FOV: 45 degrees; 1932 by 1932 pixels — 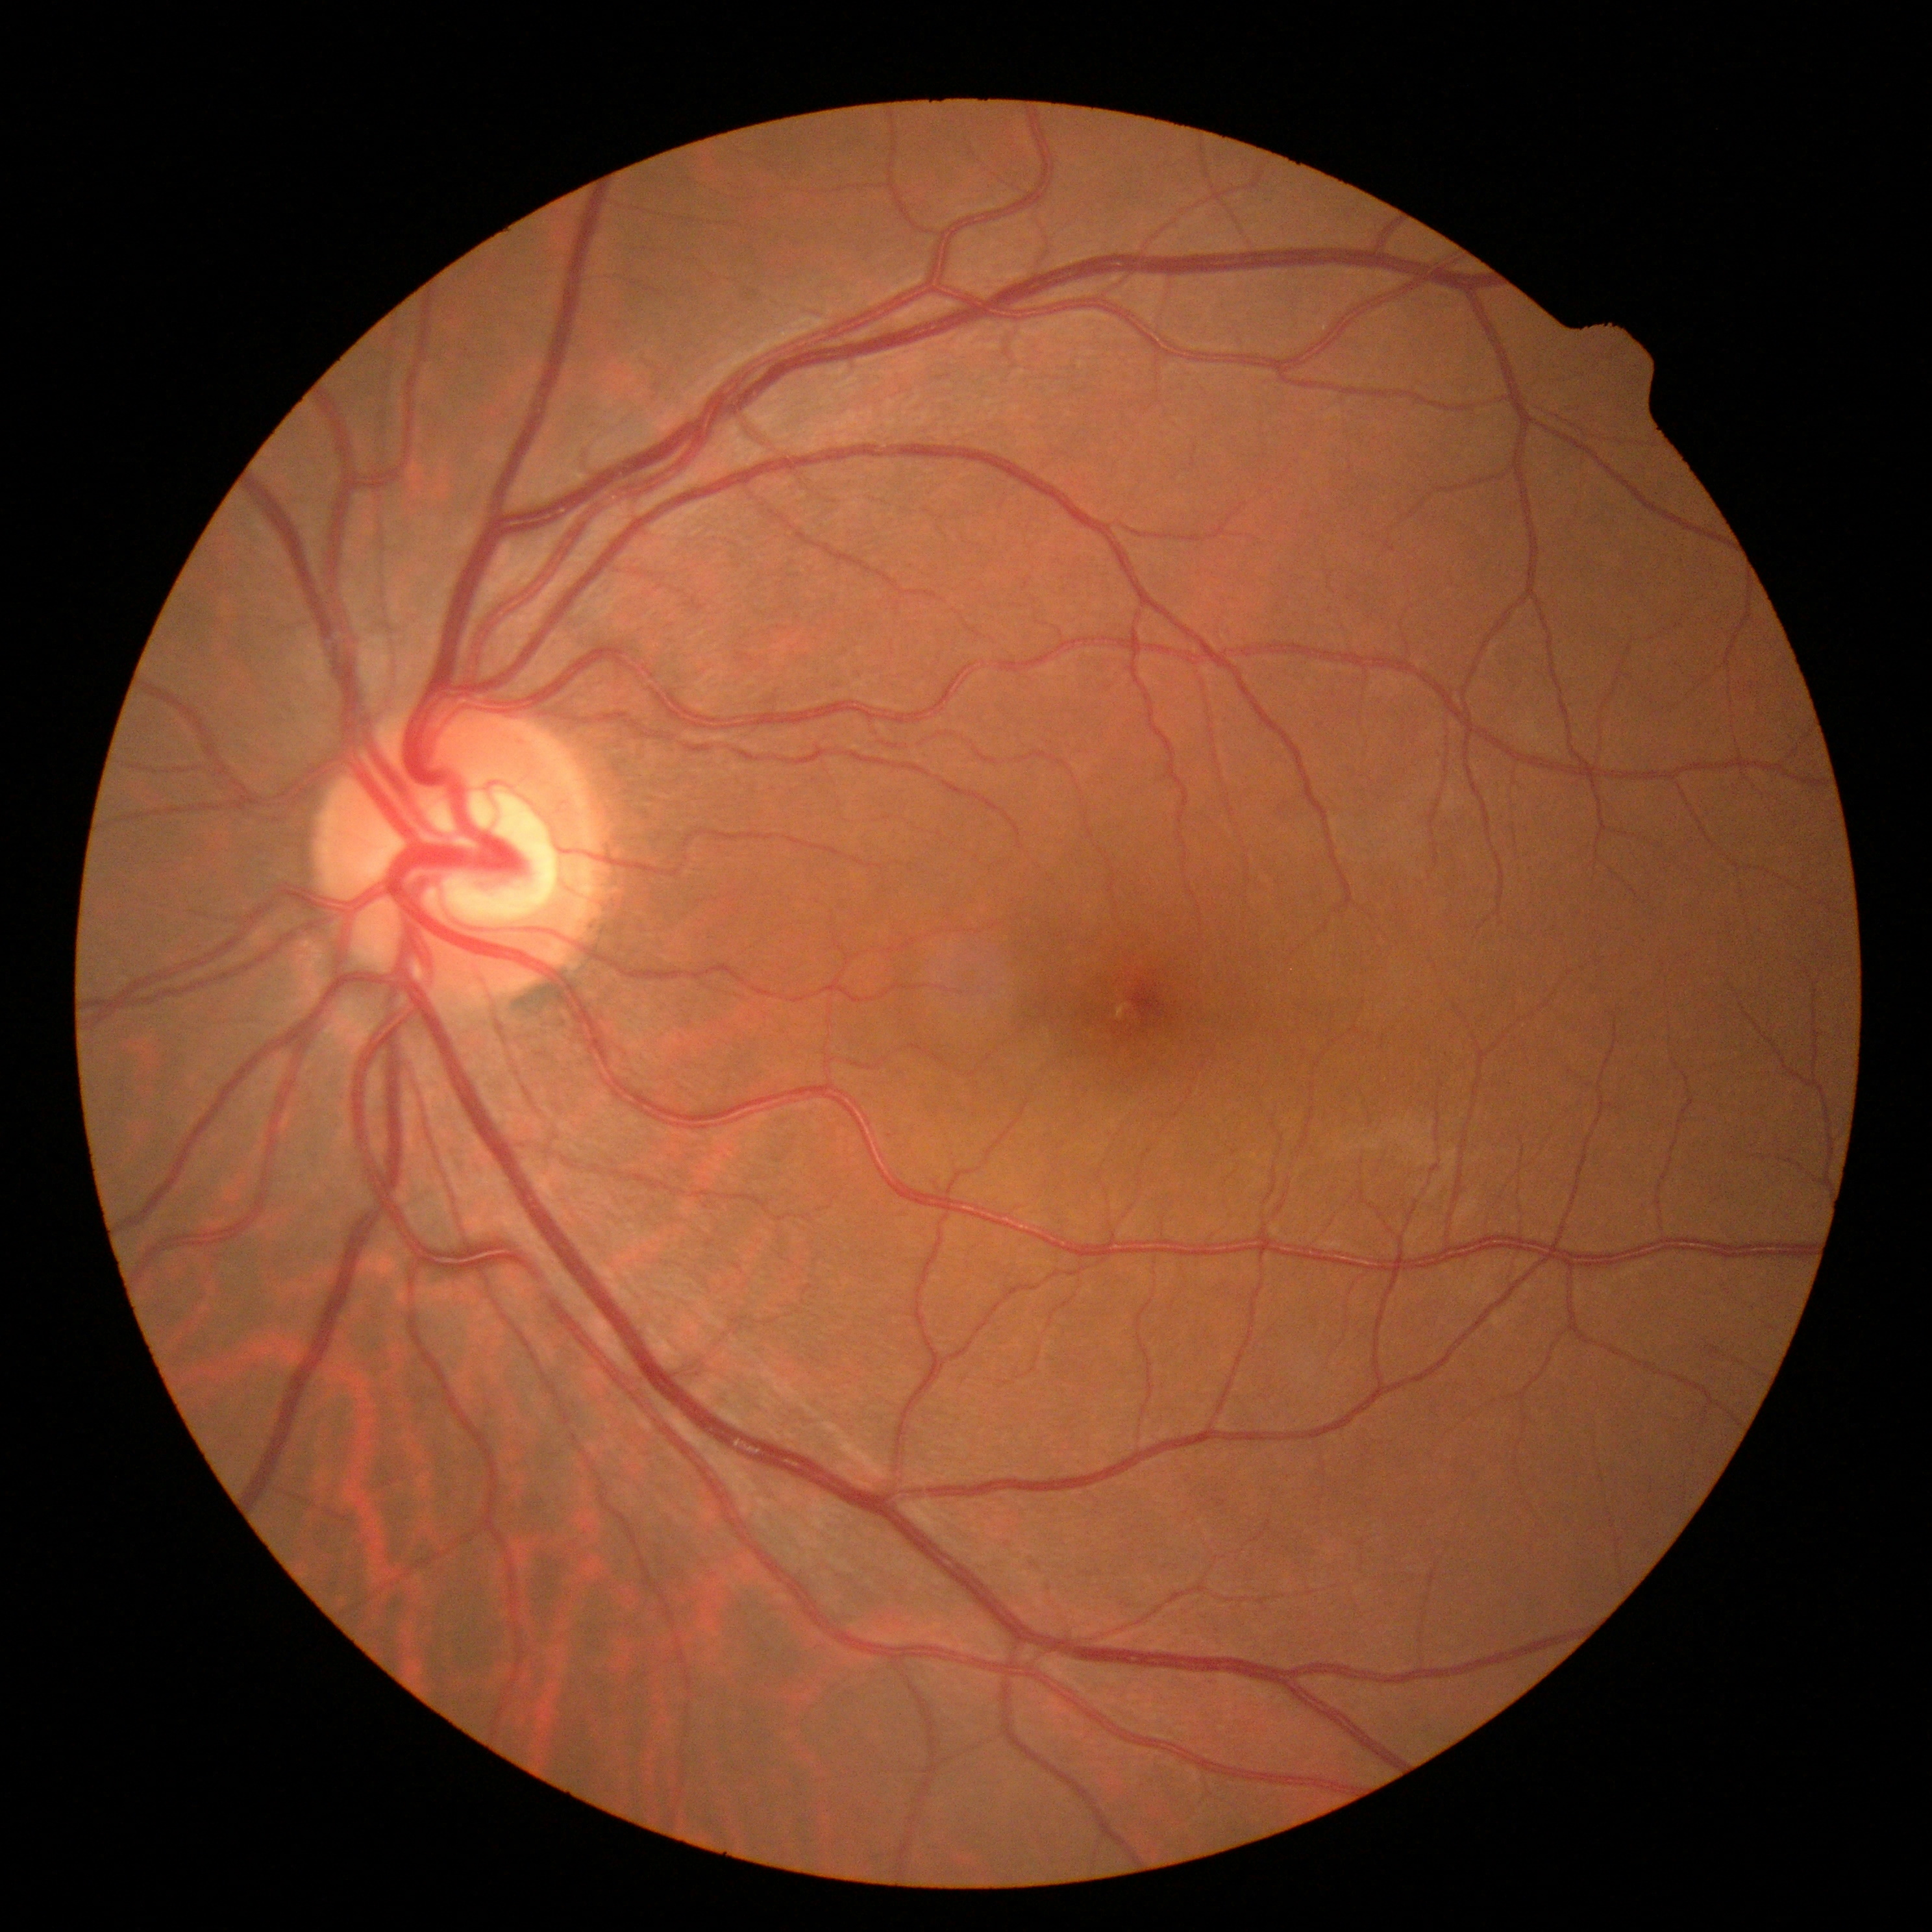
Diabetic retinopathy (DR) is grade 0.